Image size 1440x1080 · pediatric retinal photograph (wide-field) · Natus RetCam Envision, 130° FOV:
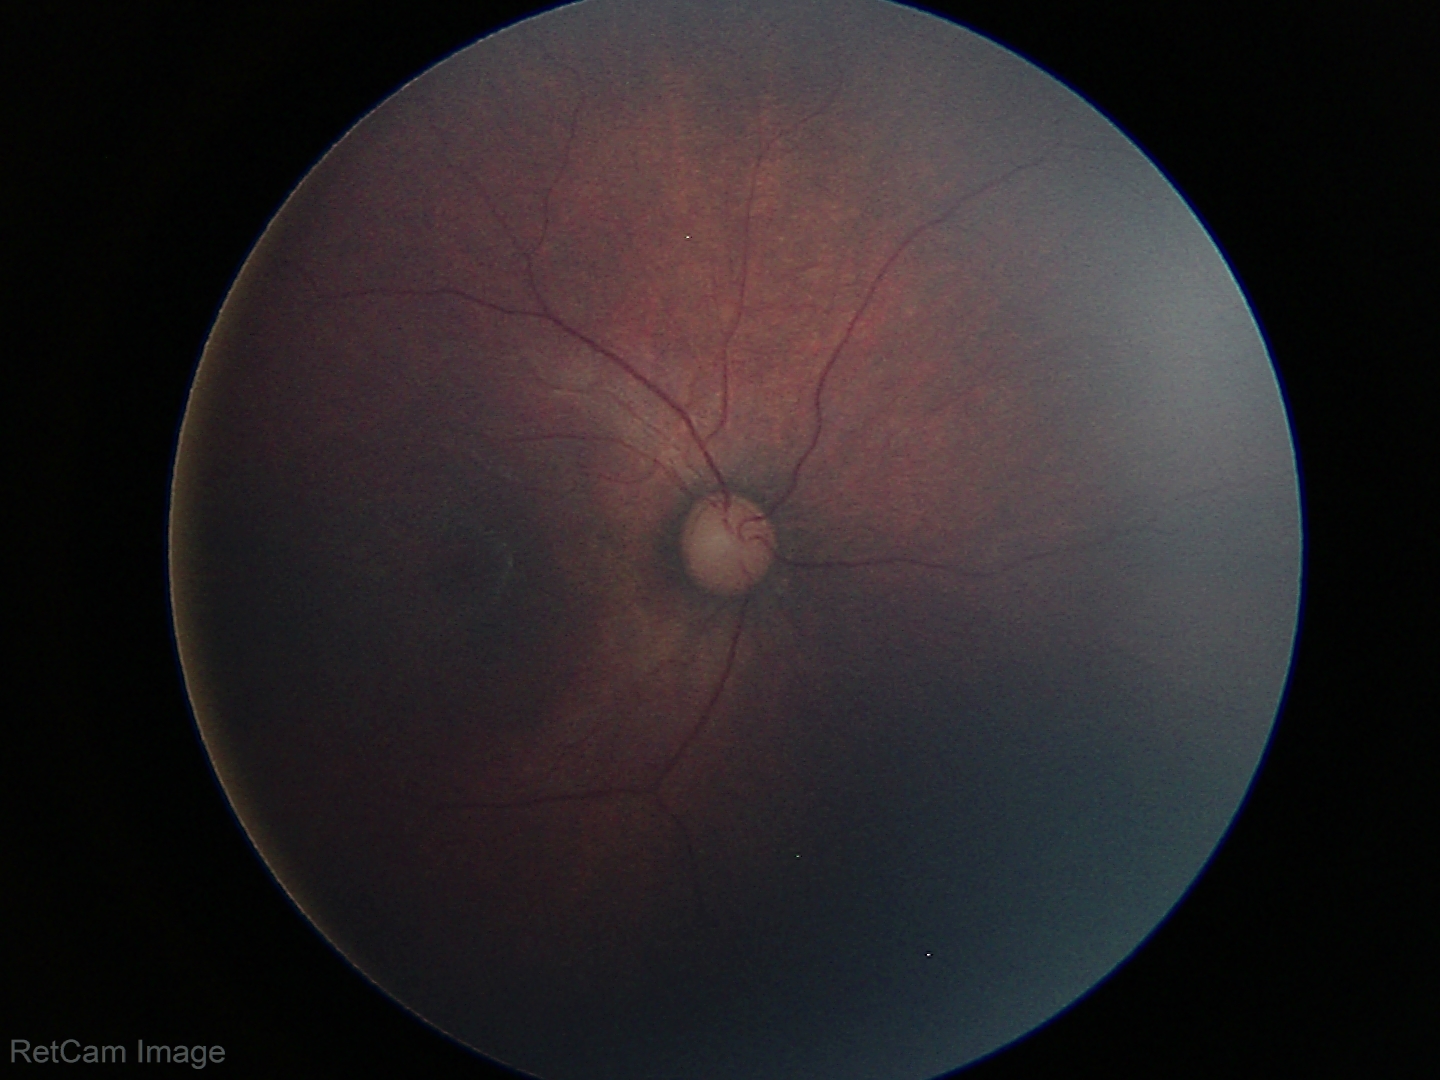
Assessment: no abnormal retinal findings.